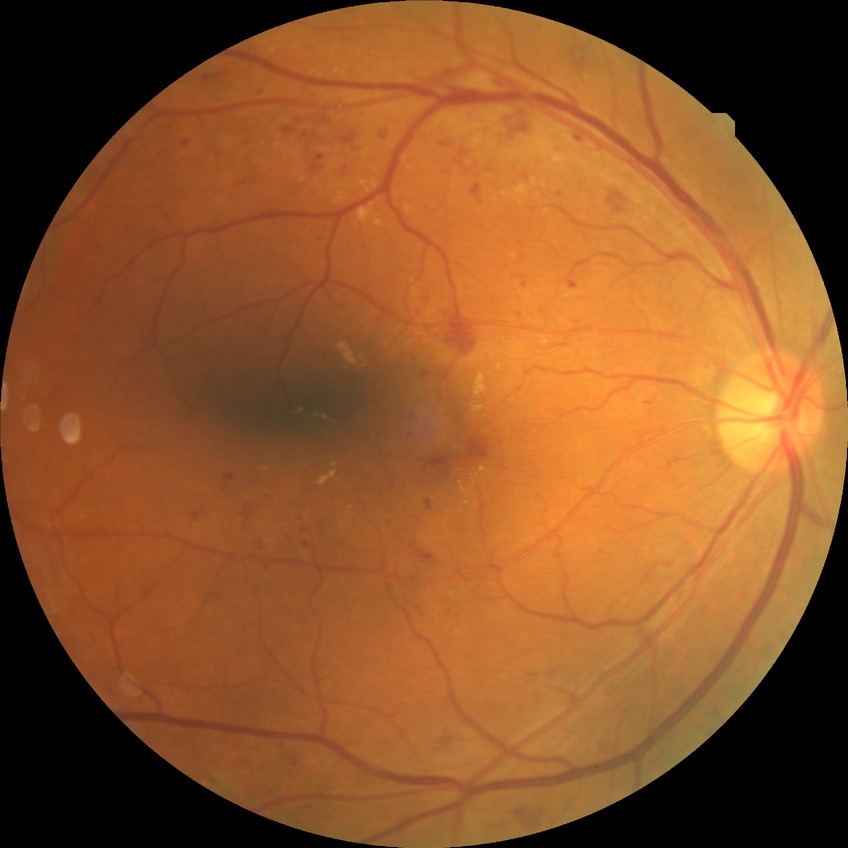 Diabetic retinopathy (DR) is SDR (simple diabetic retinopathy).